1924x1556; ultra-widefield (UWF) fundus image: 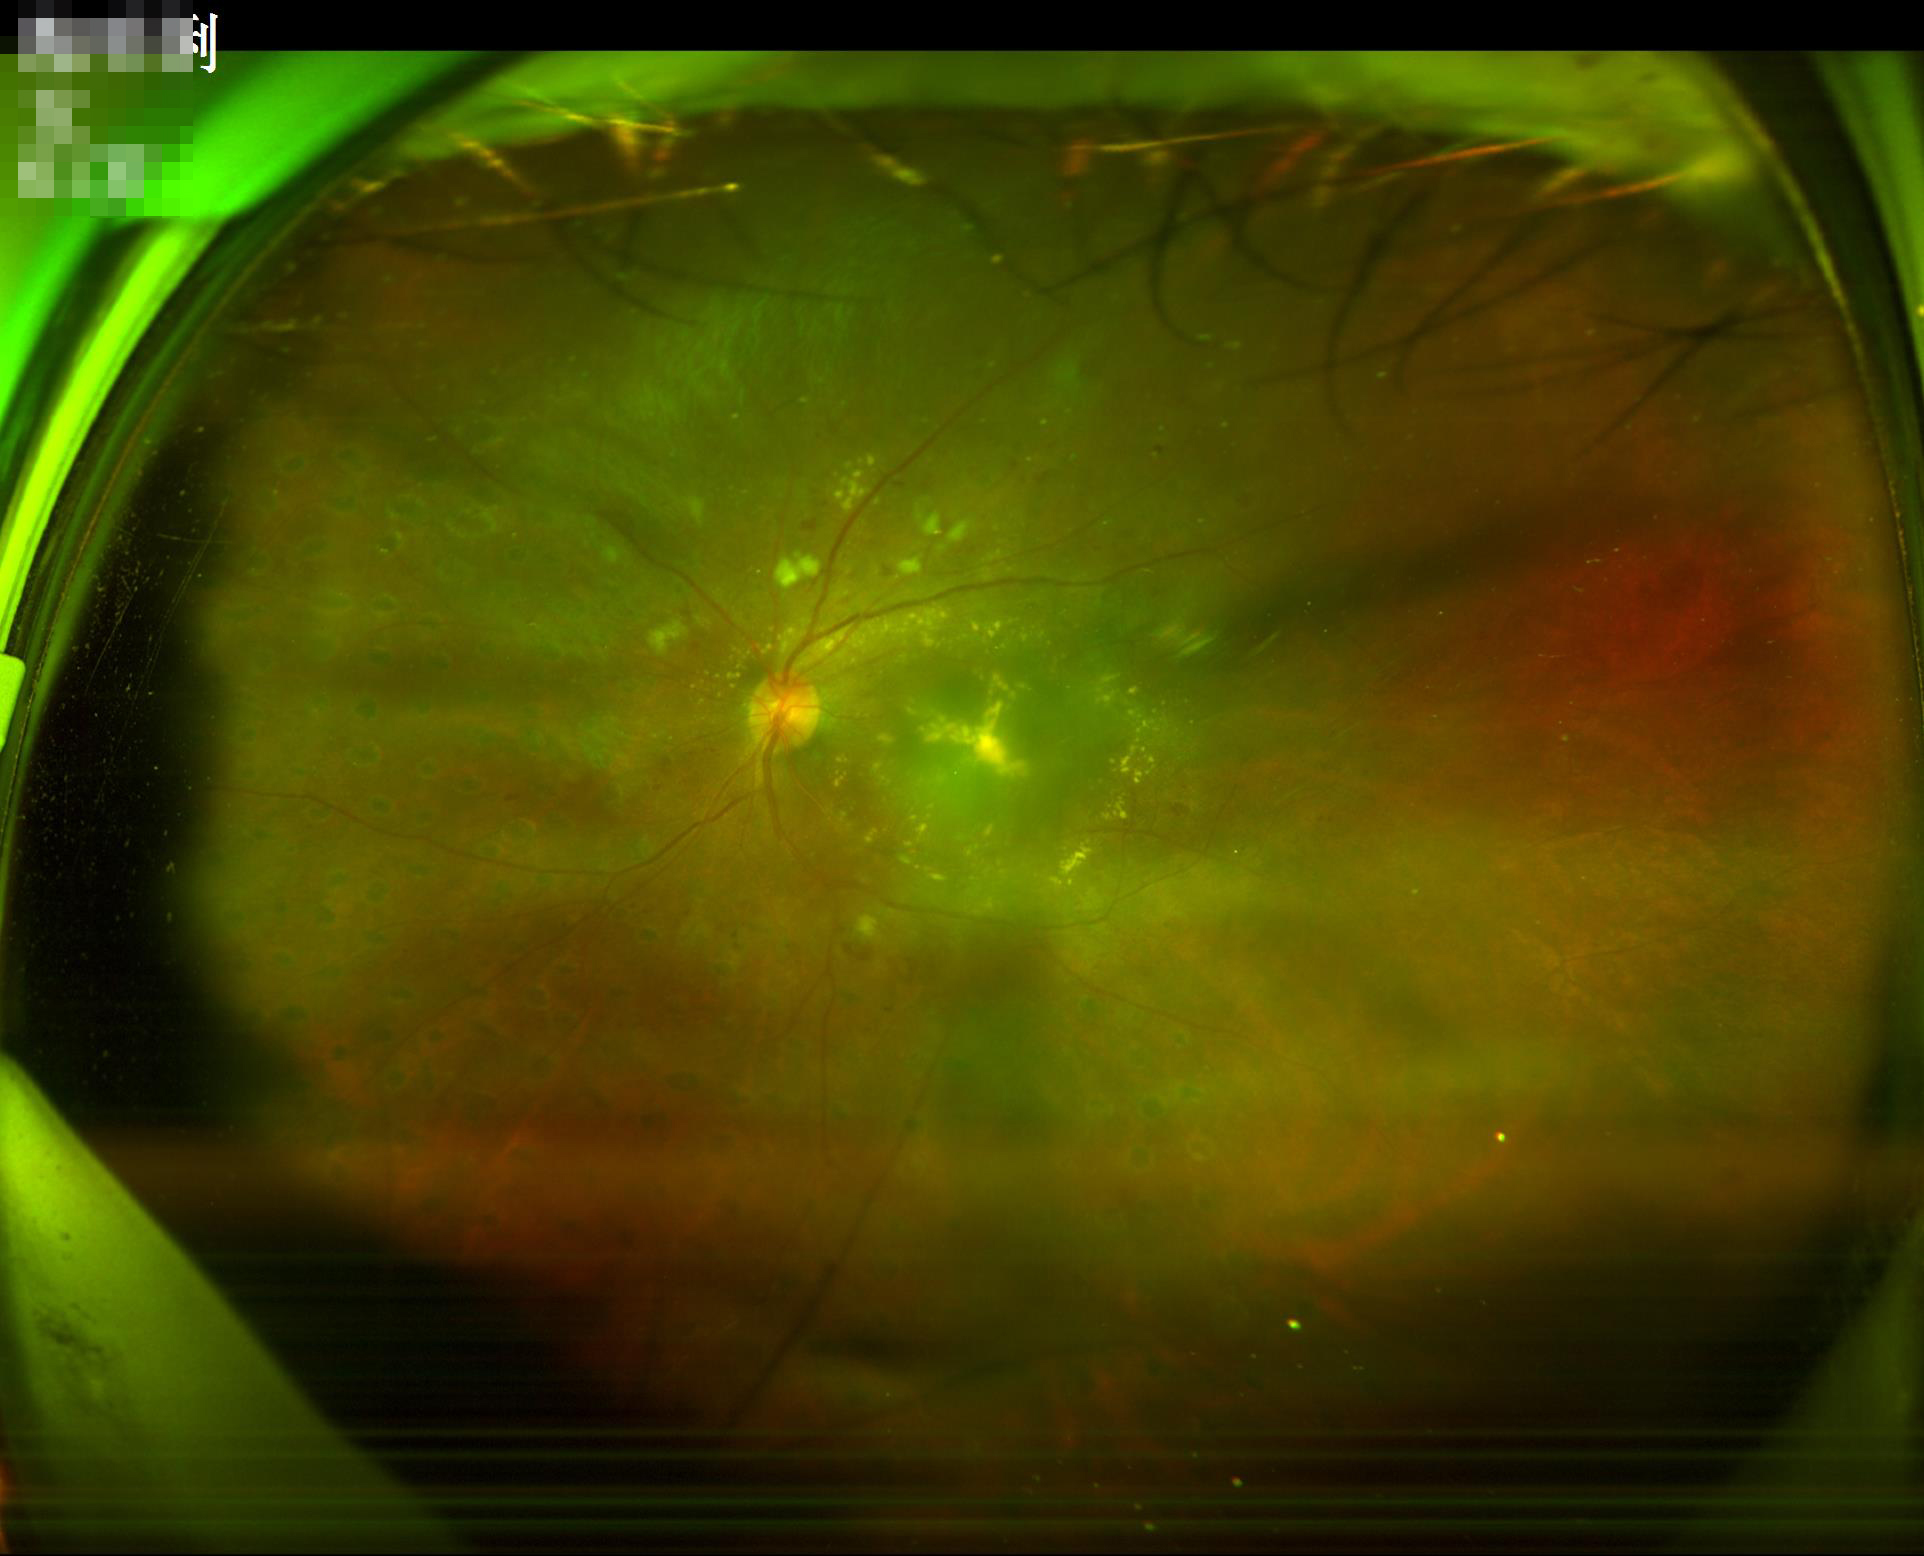 Image quality is inadequate for diagnostic use.
Out of focus; structures are indistinct.
Contrast is good.